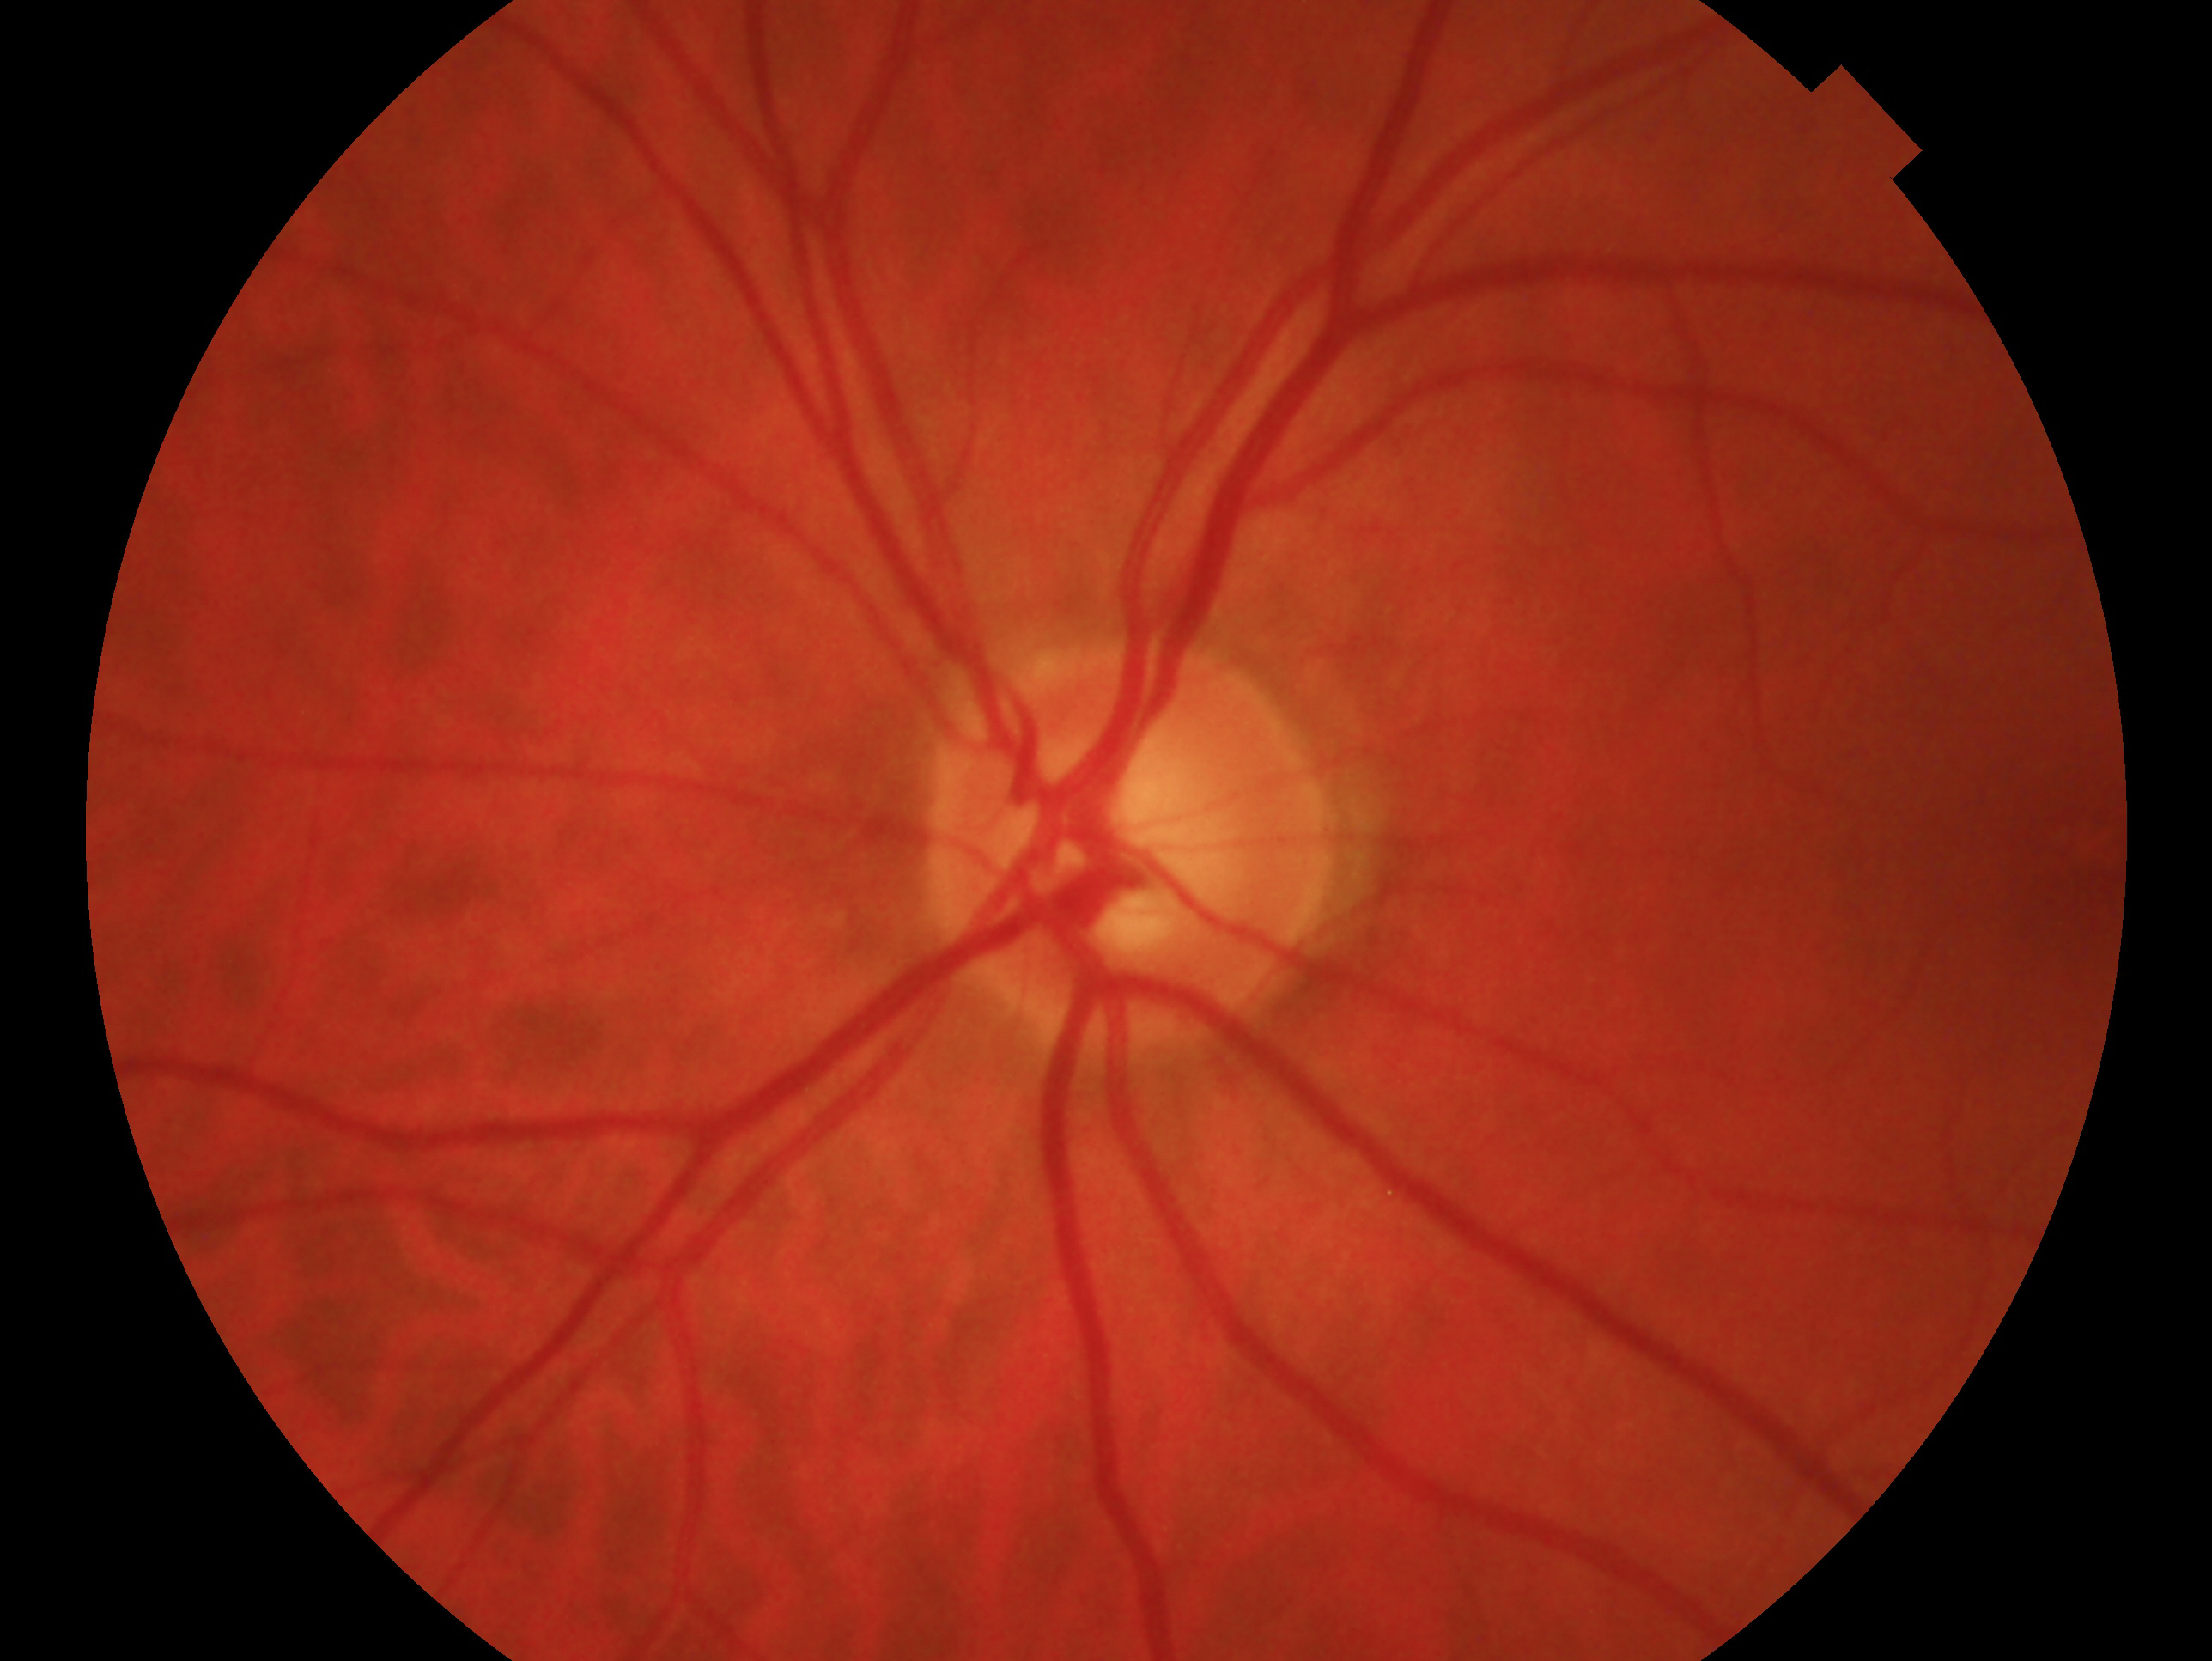 • laterality: oculus sinister
• diagnosis: glaucoma